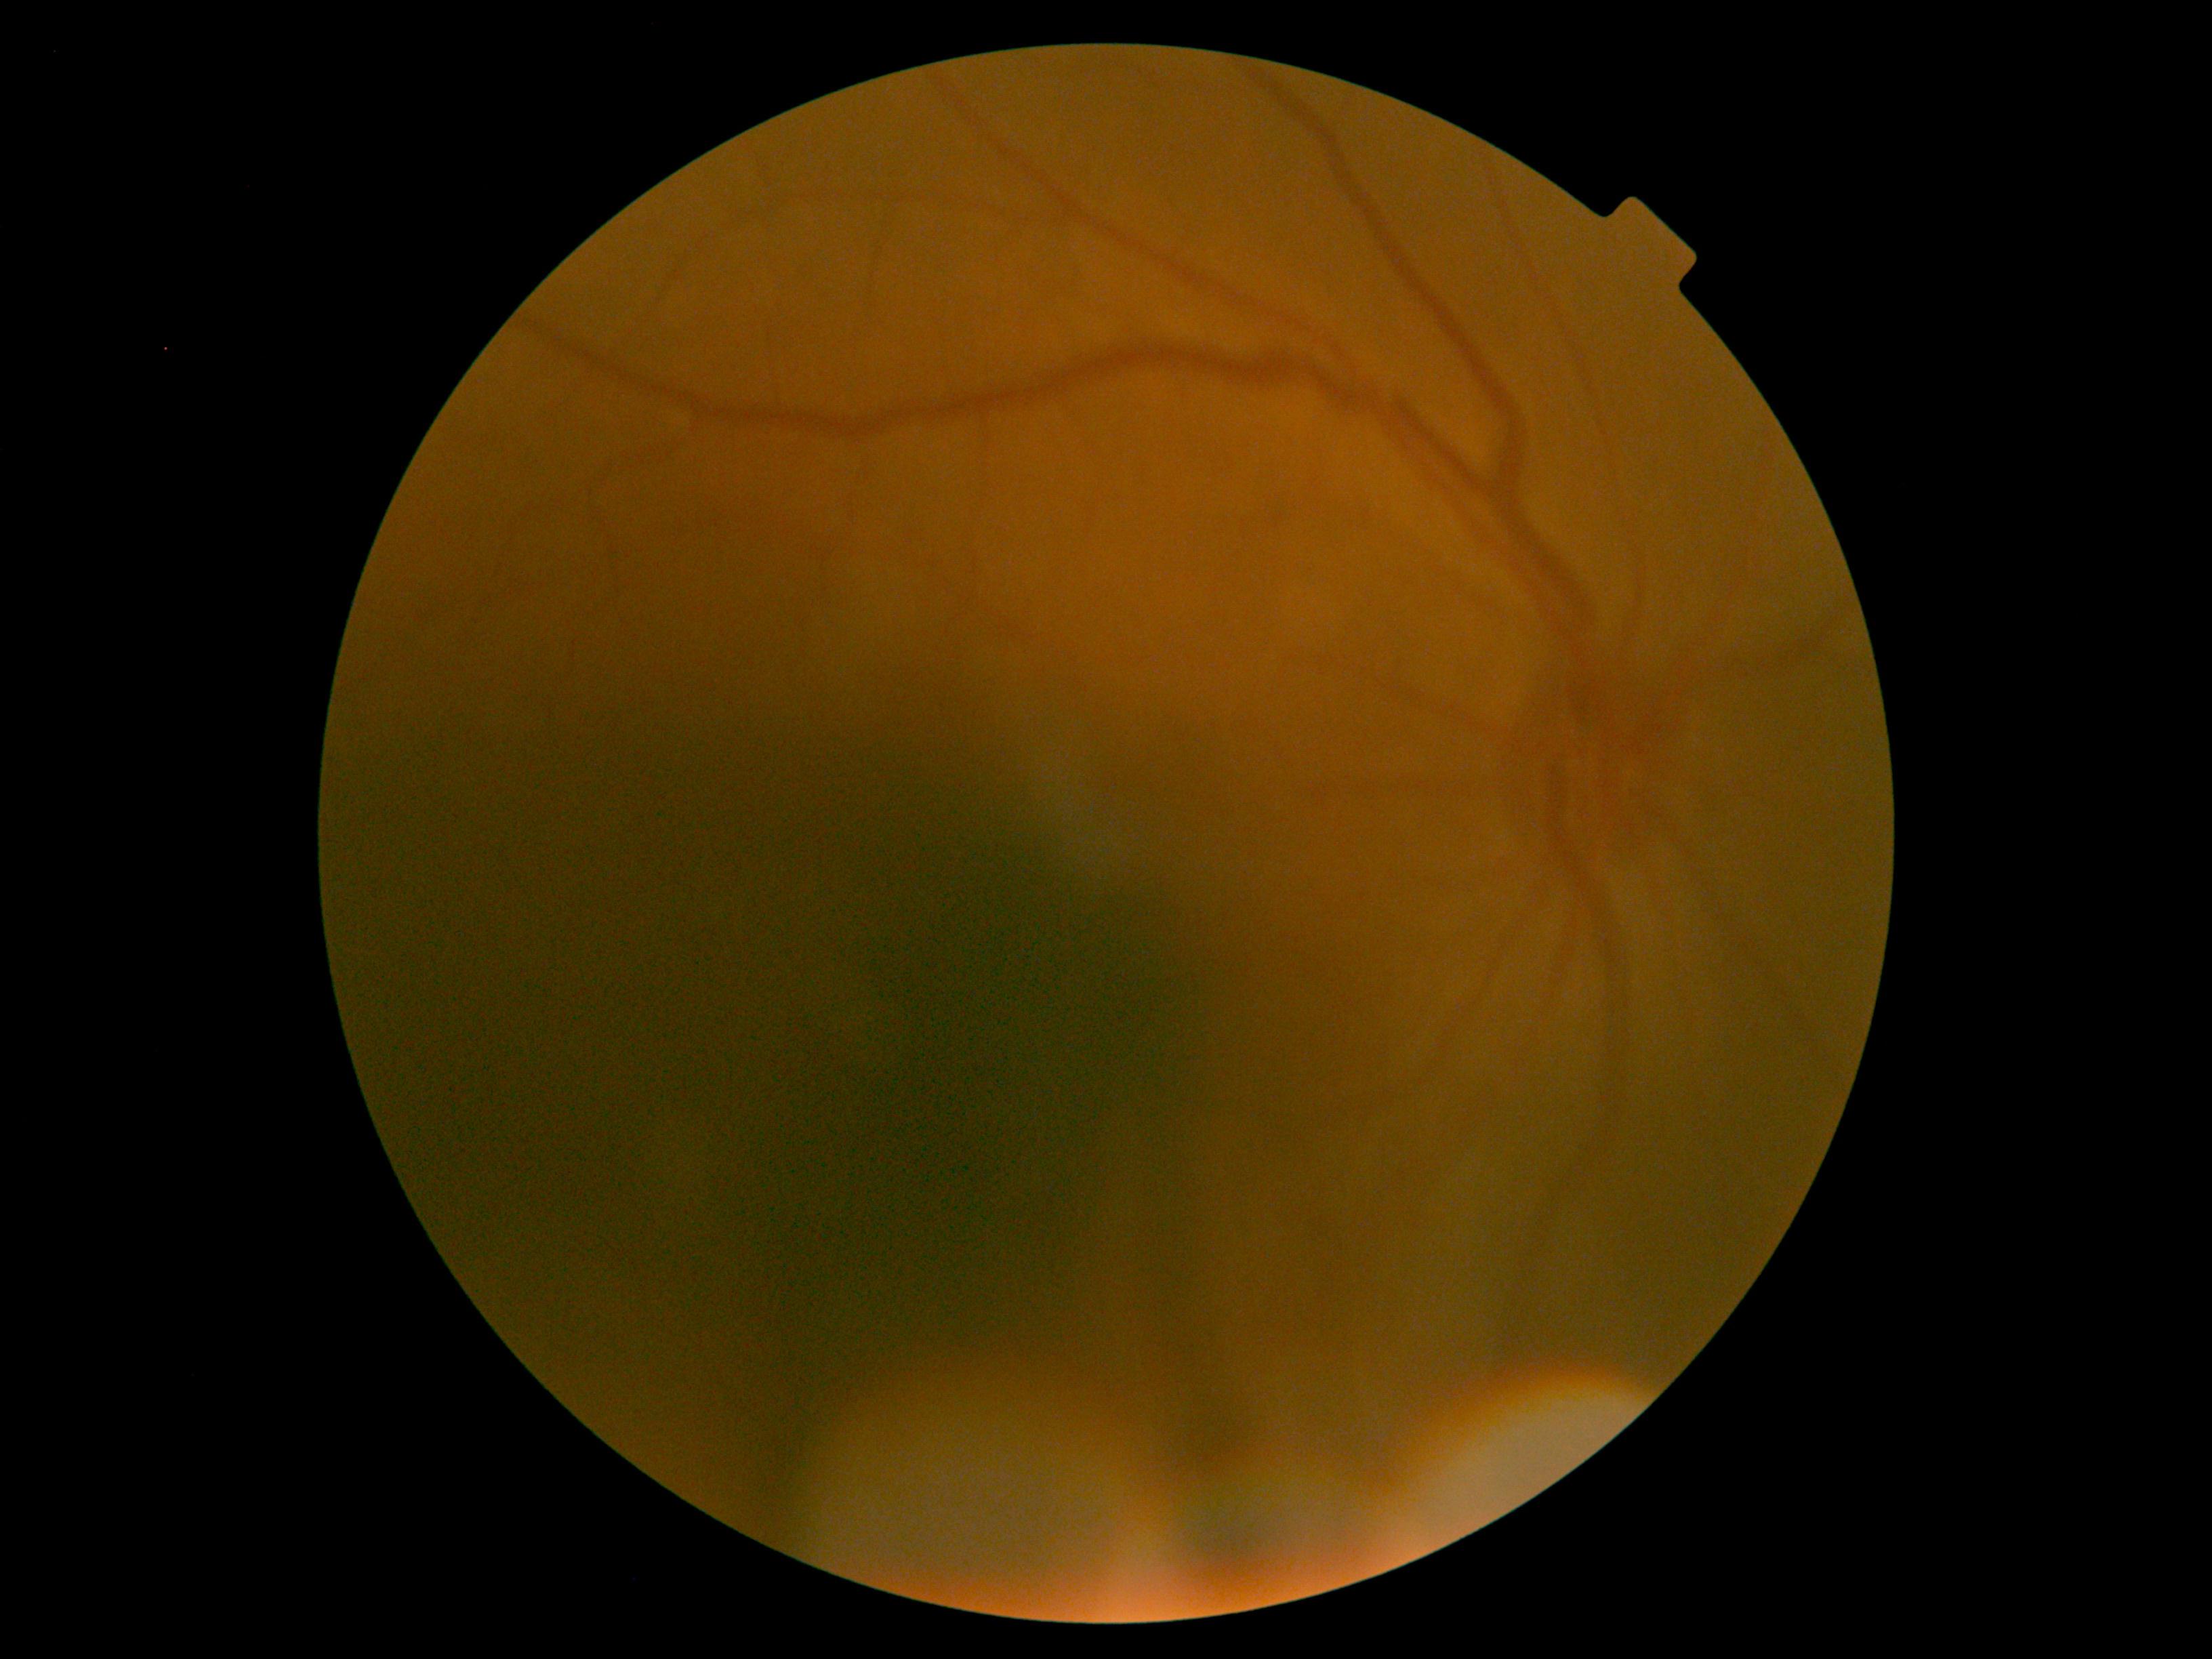
- DR stage — grade 0 (no apparent retinopathy)